Optic disc region of a color fundus photo. Mydriatic: 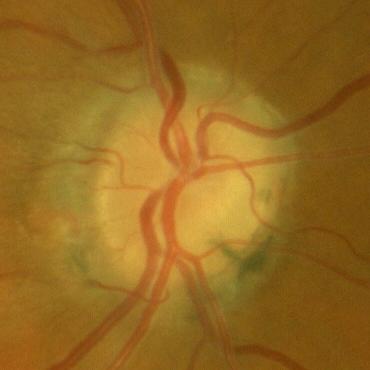
Optic disc appearance consistent with no glaucomatous changes.